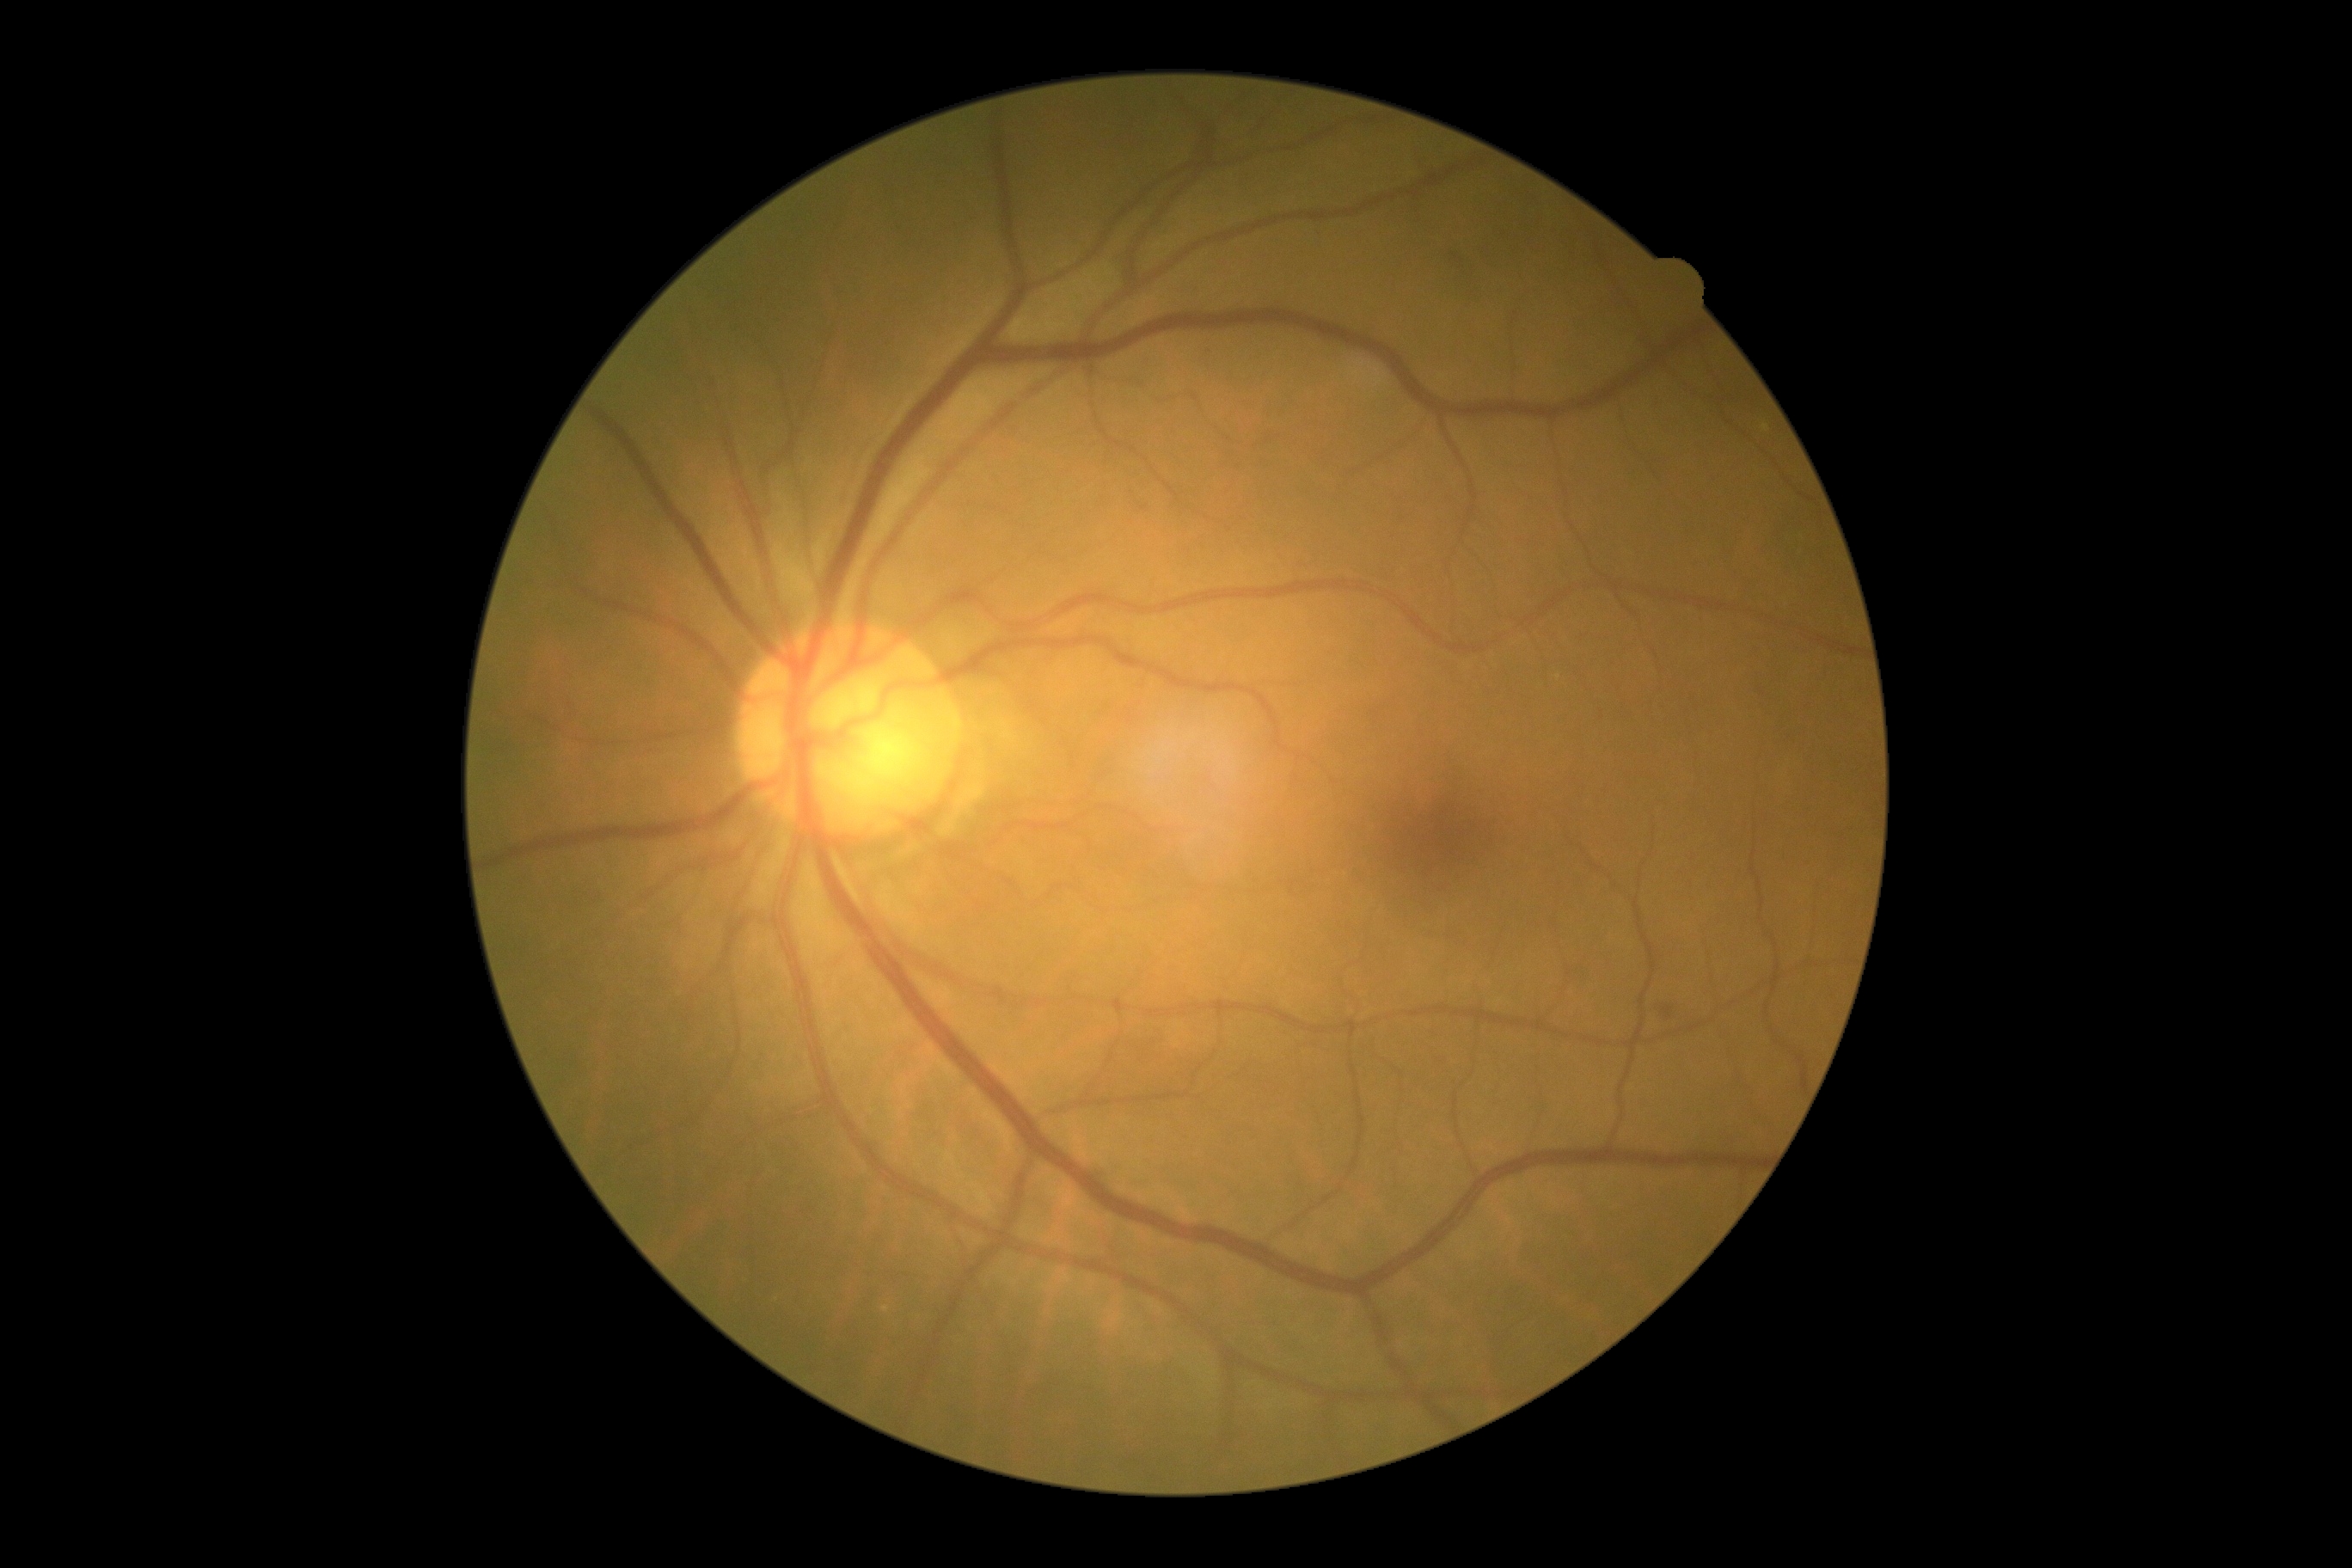

DR severity: moderate NPDR (grade 2).